Modified Davis grading.
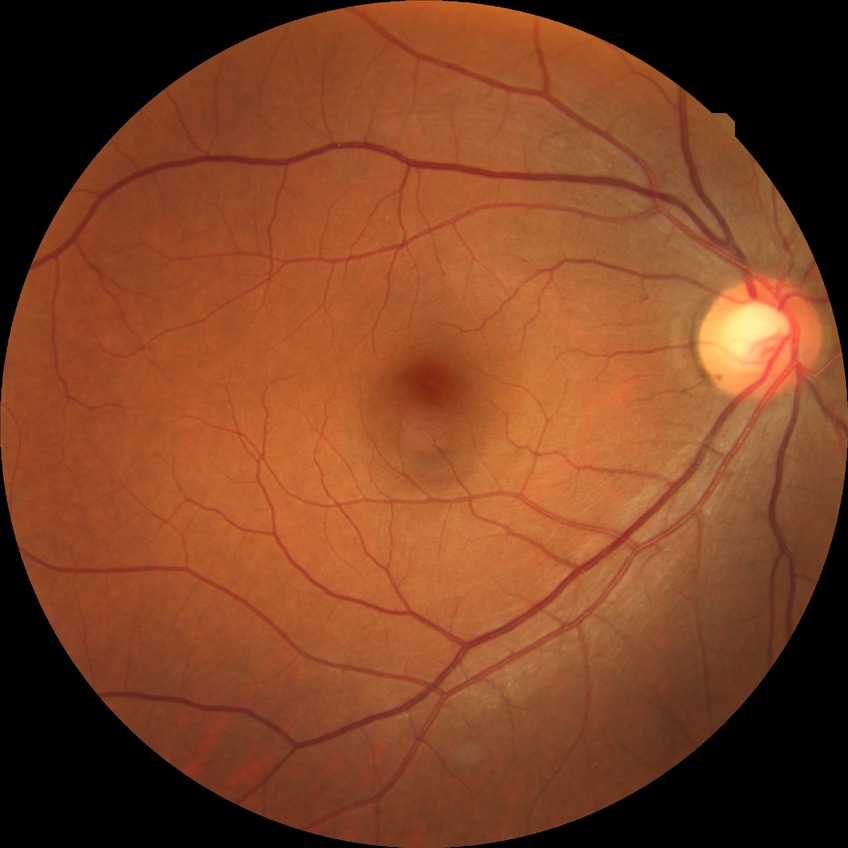
• Davis stage — NDR